Image size 2048x1536
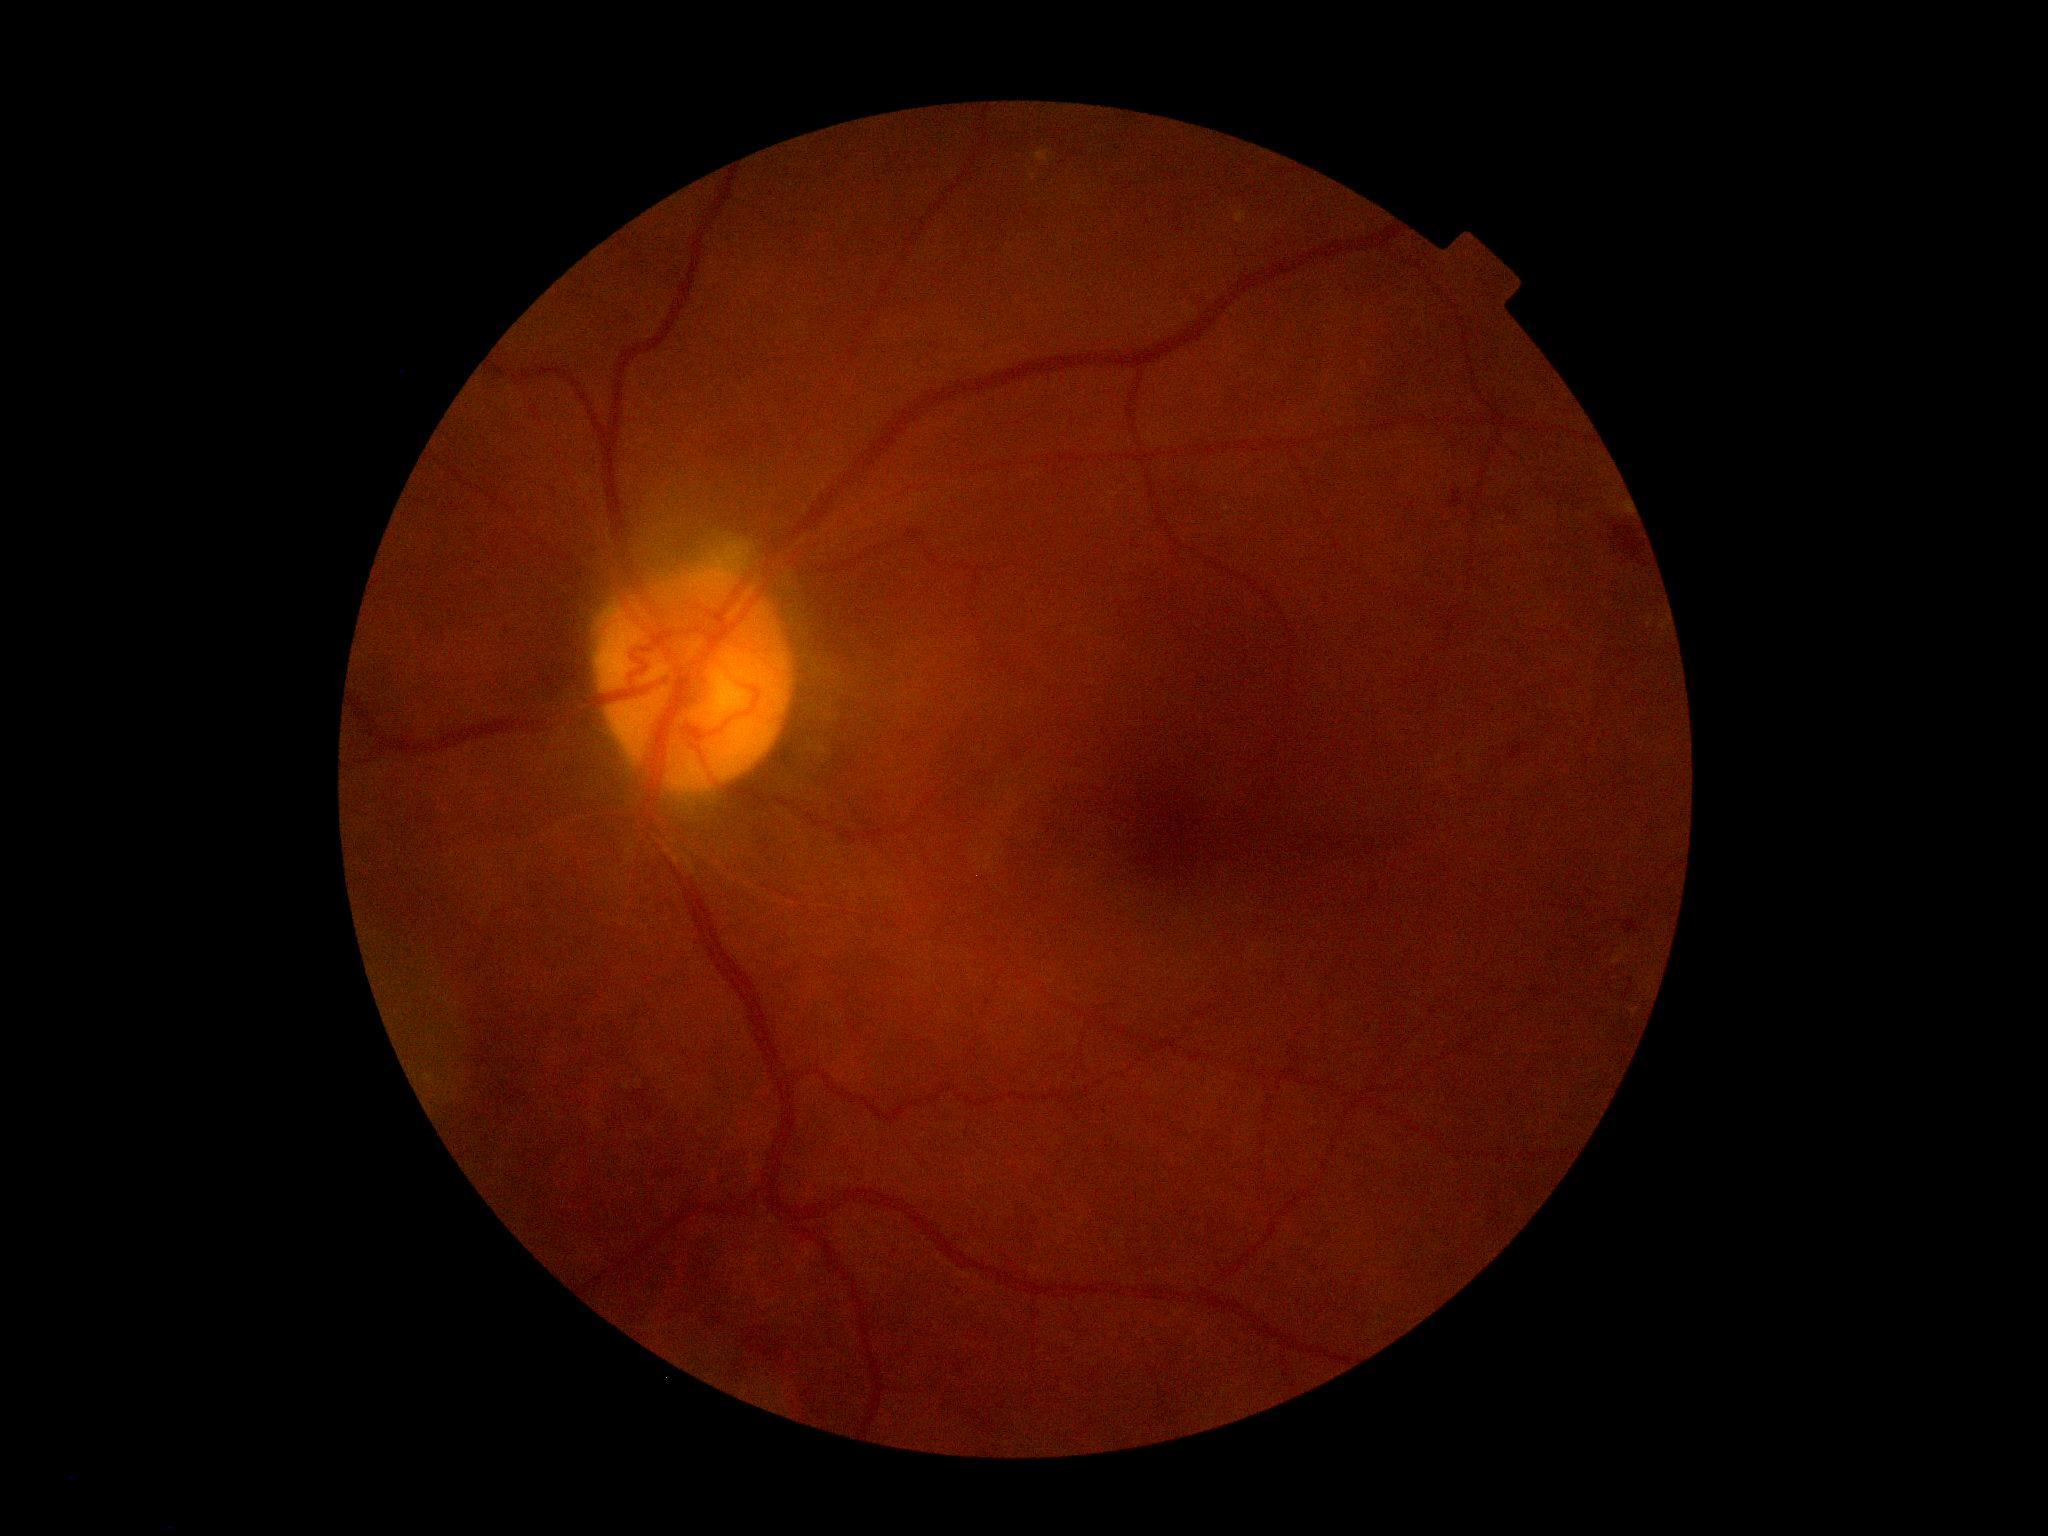 retinopathy grade: 2/4.